100° field of view (Phoenix ICON) · wide-field fundus photograph from neonatal ROP screening: 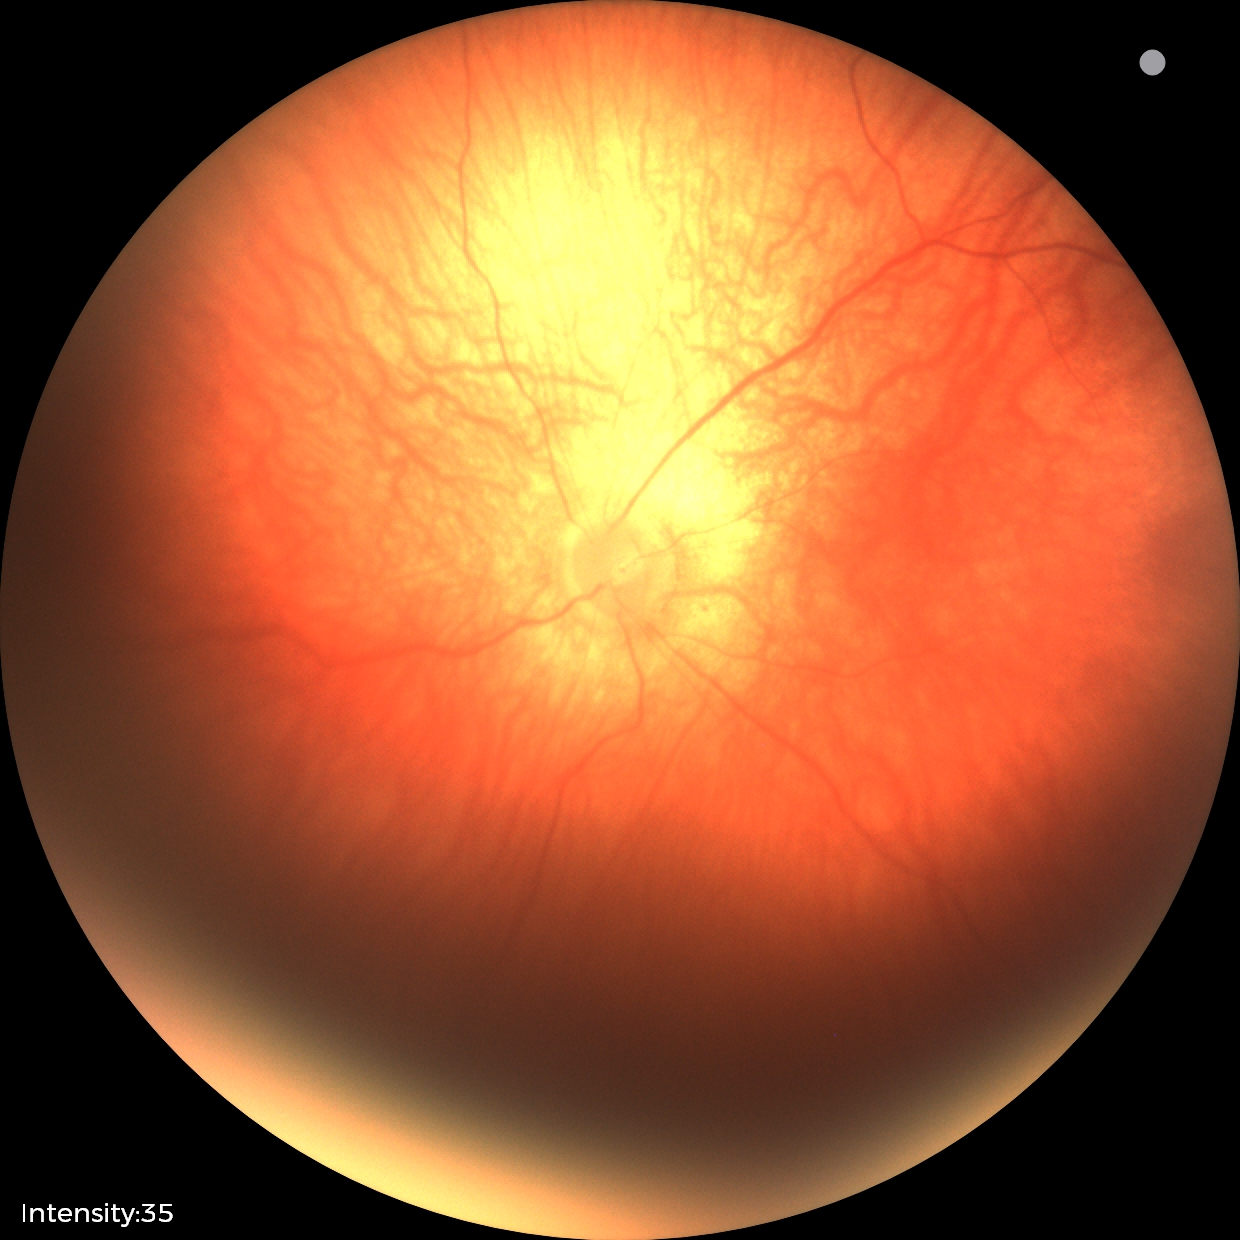 Impression: physiological finding.